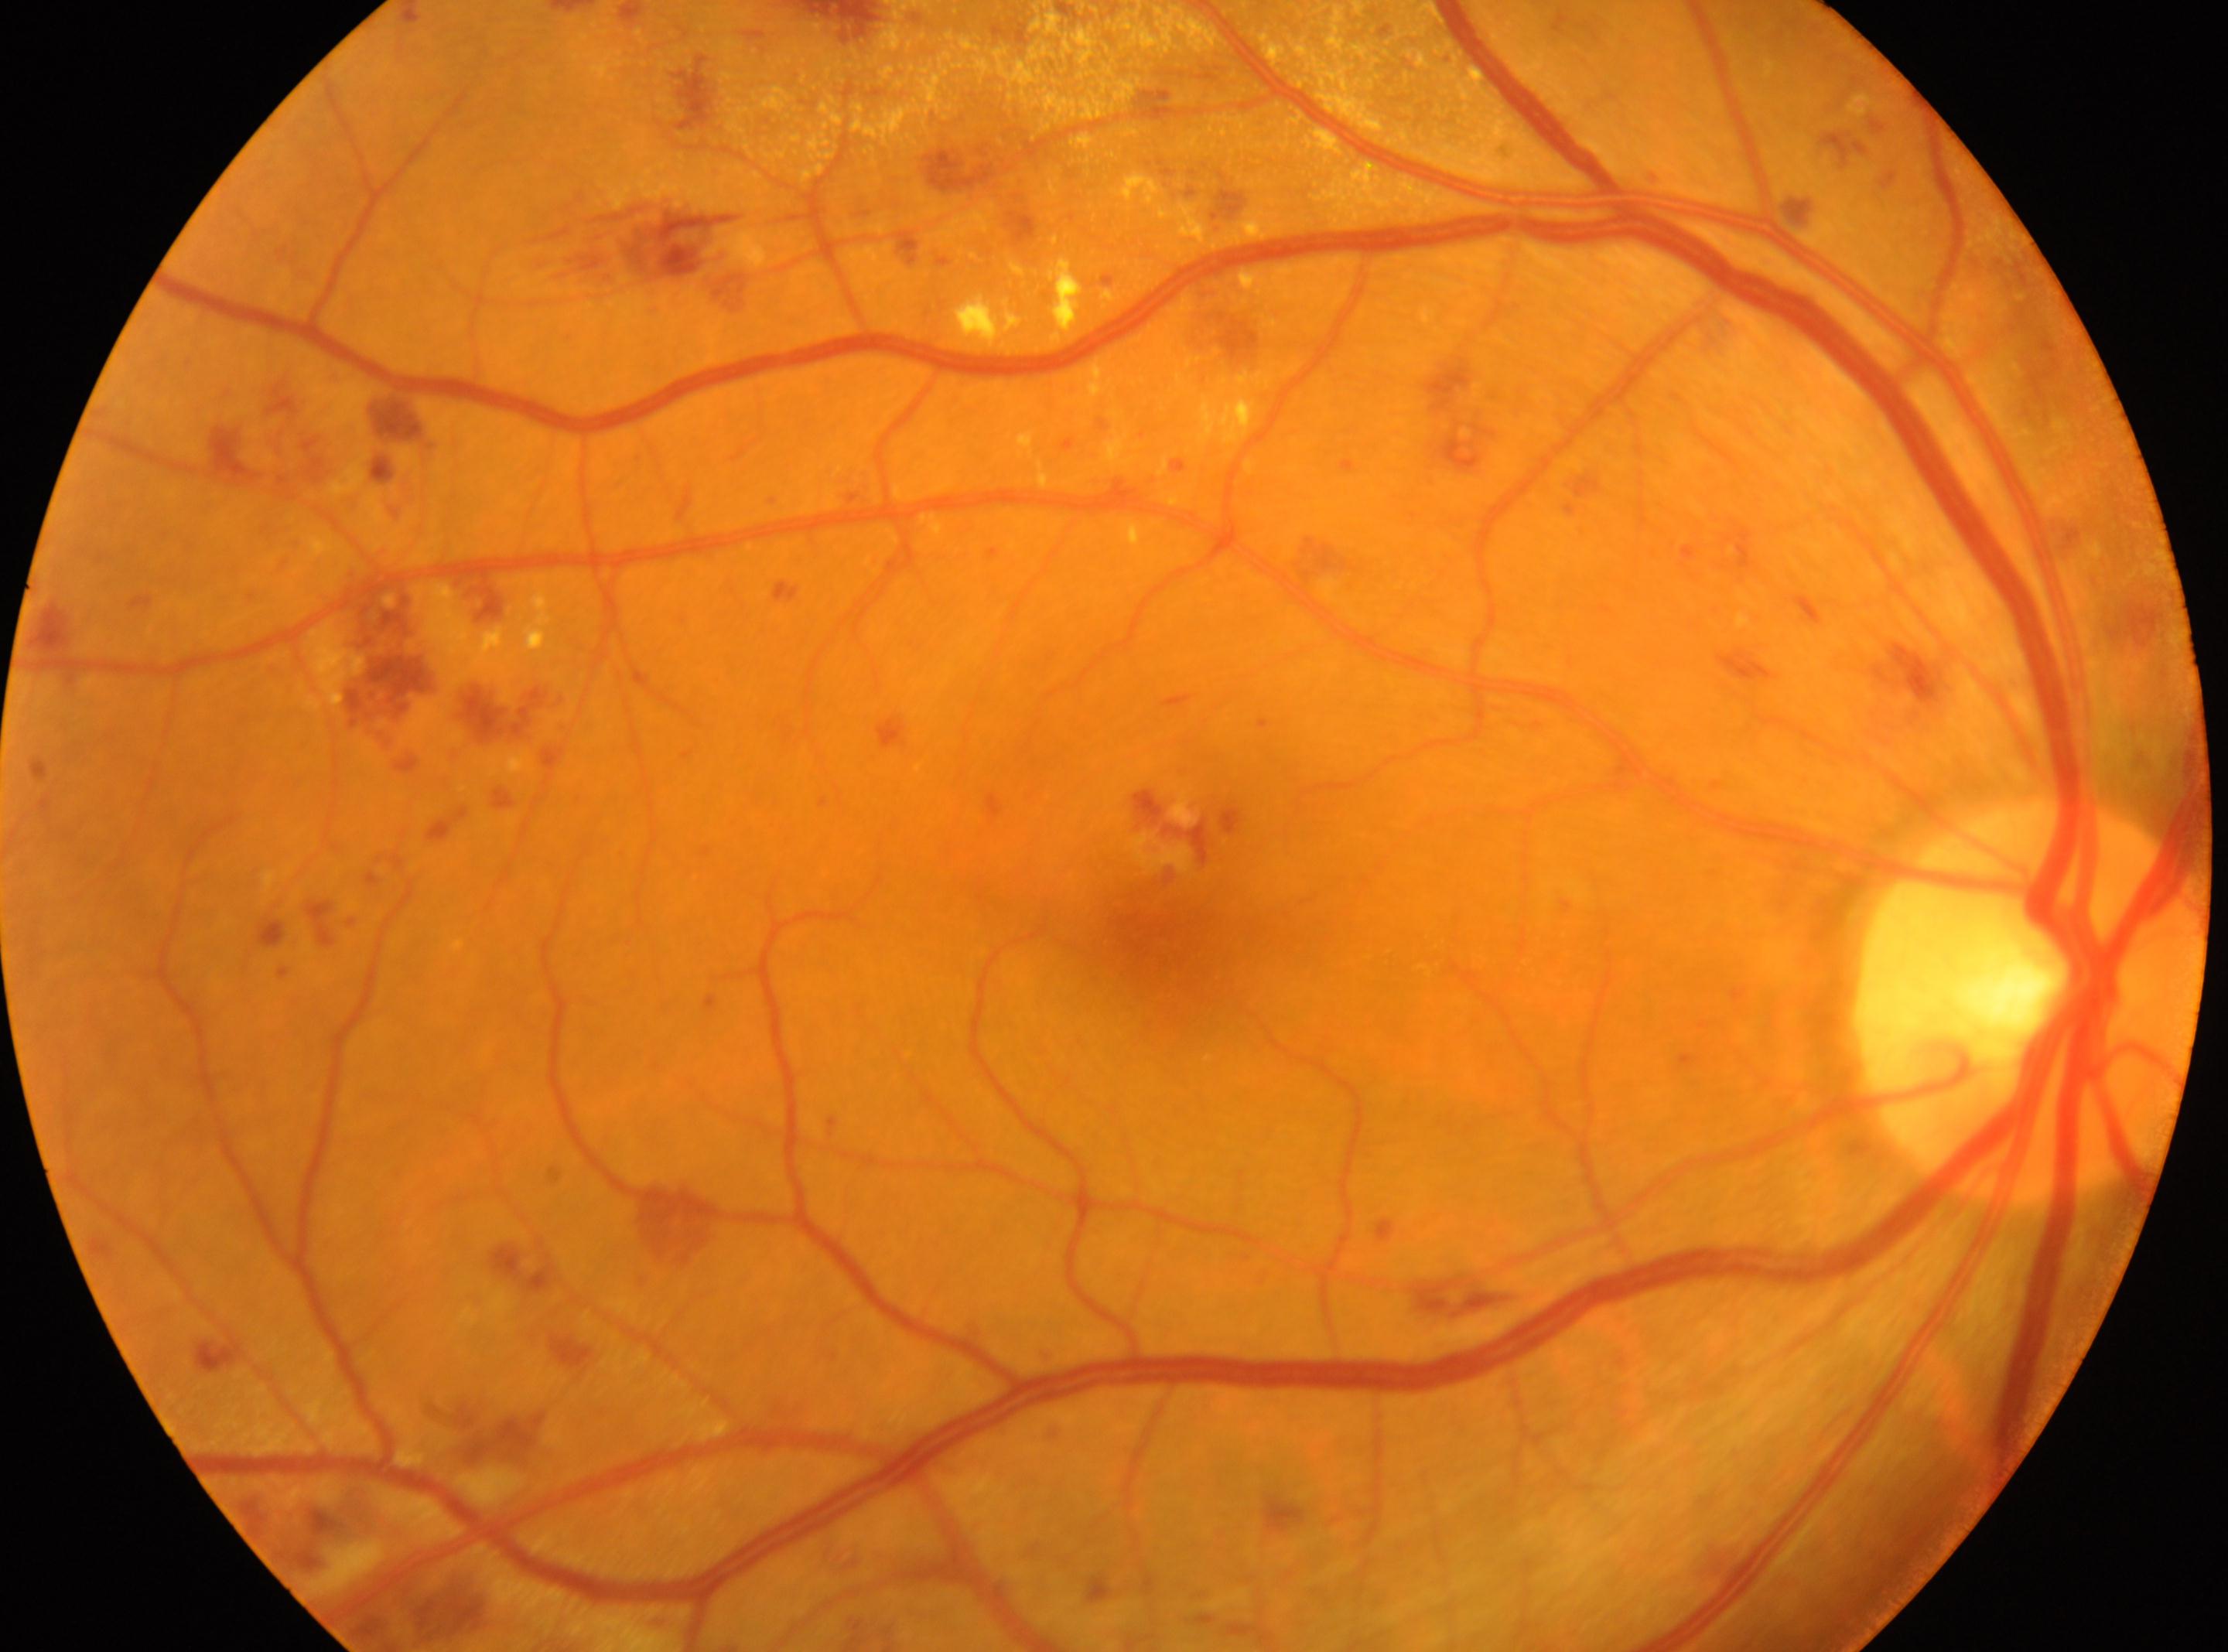
{"fovea": "1162, 928", "eye": "oculus dexter", "dr_grade": "severe non-proliferative diabetic retinopathy (grade 3)", "optic_disc": "2030, 1001"}